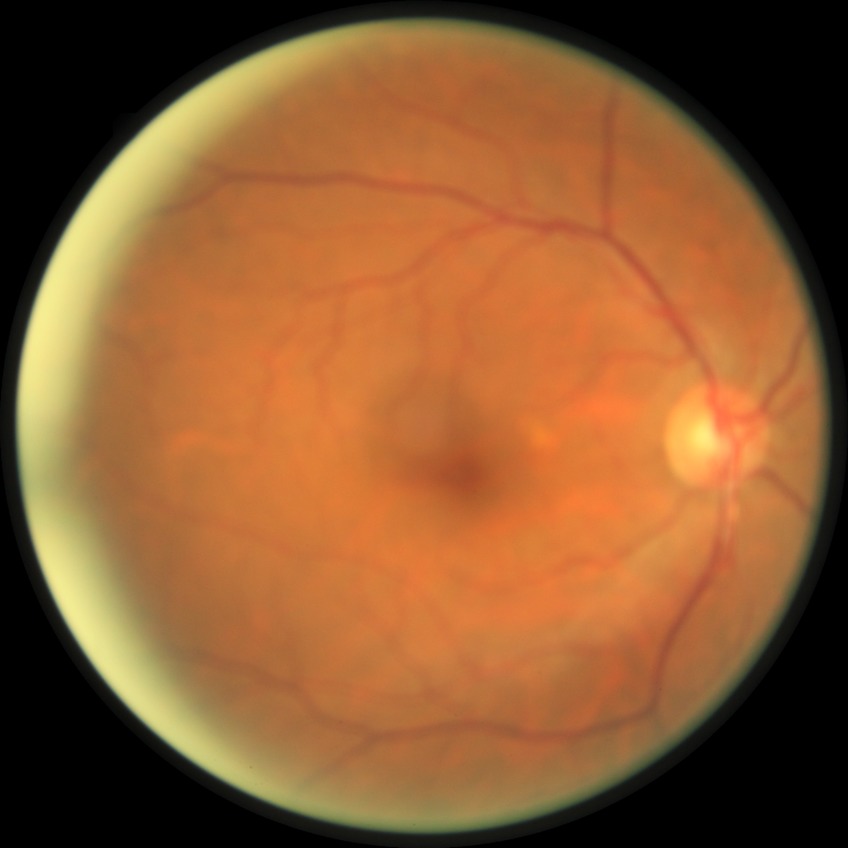

Assessment:
- diabetic retinopathy (DR): NDR (no diabetic retinopathy)